Infant wide-field fundus photograph; 1440 x 1080 pixels.
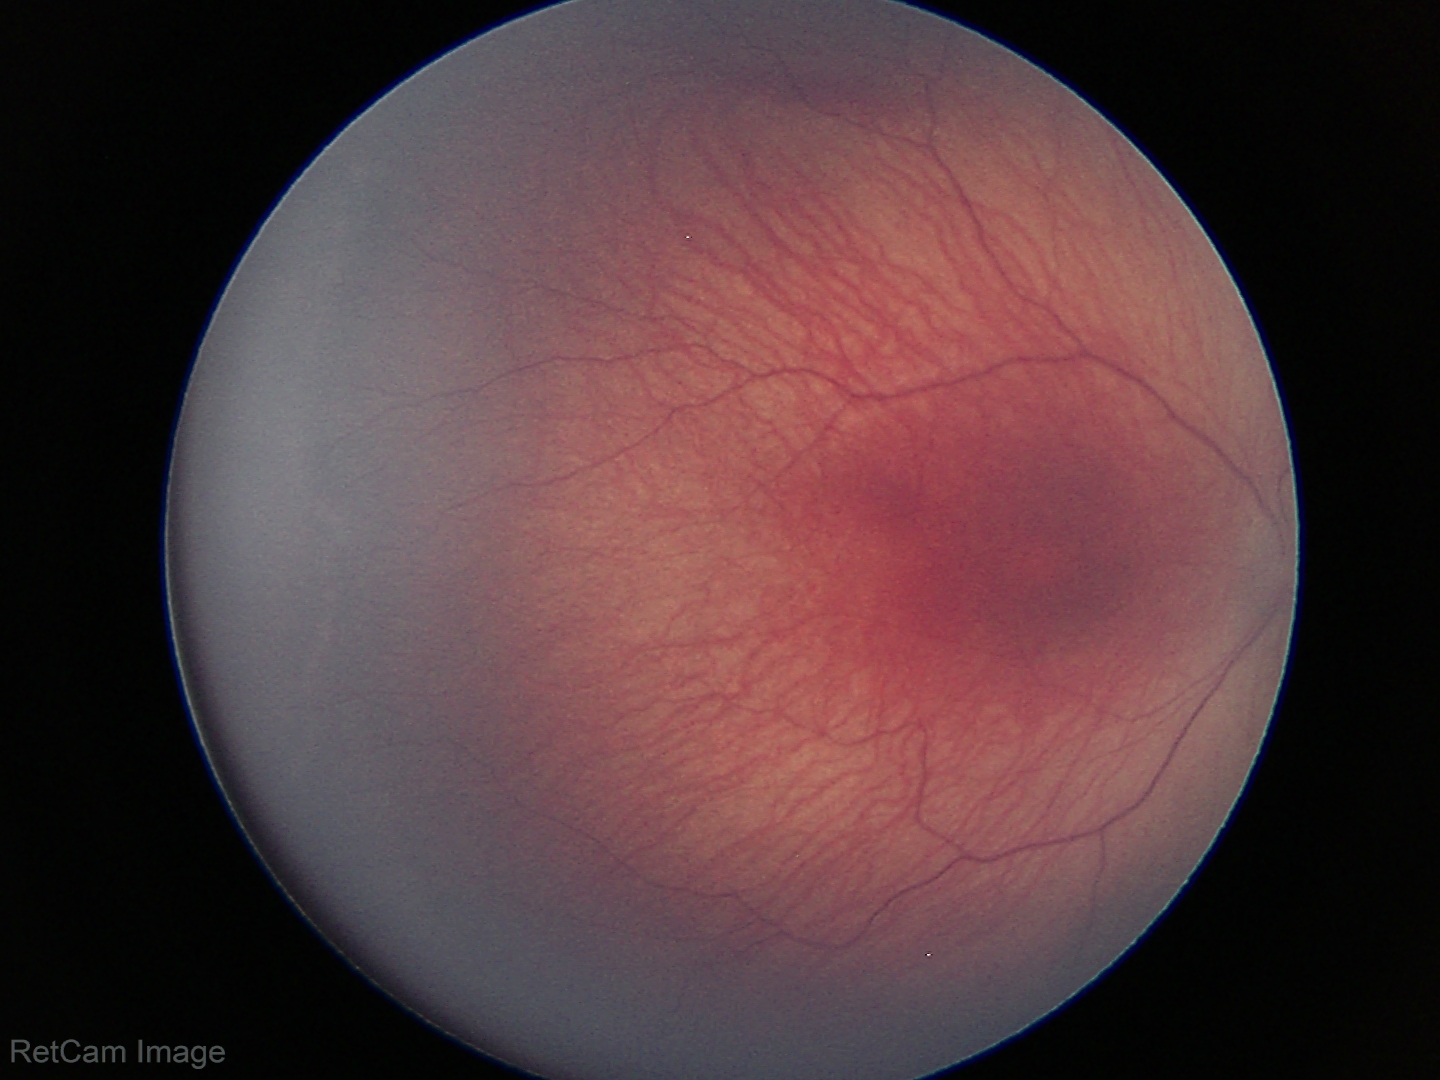

From an examination with diagnosis of ROP stage 1. Plus disease absent.